848x848: 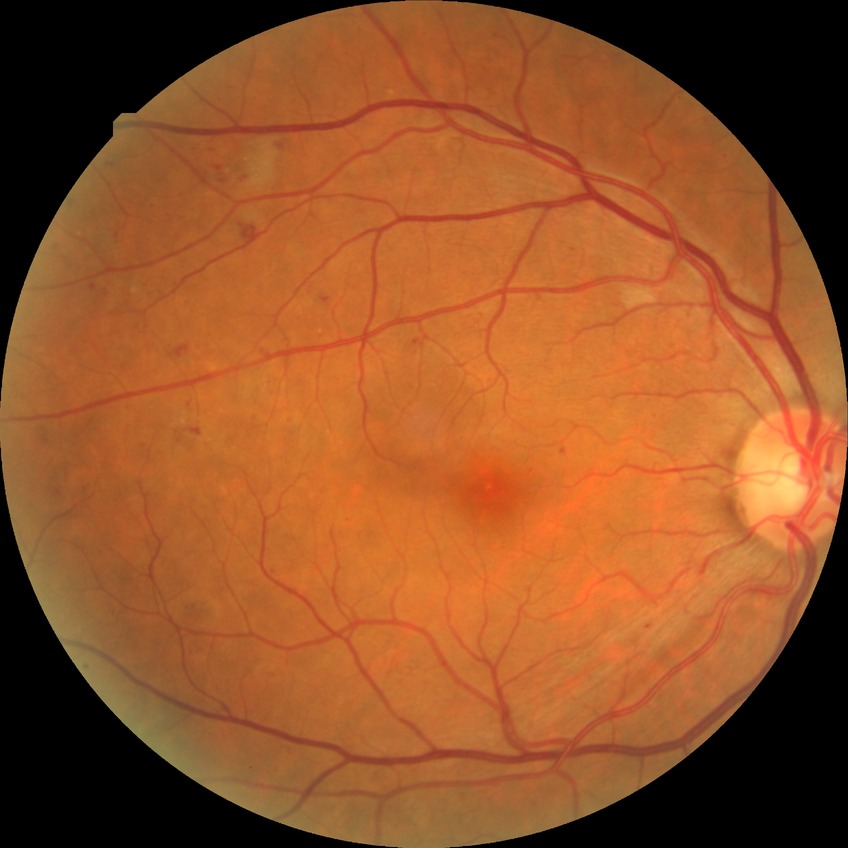

diabetic retinopathy (DR): pre-proliferative diabetic retinopathy (PPDR); DR class: non-proliferative diabetic retinopathy.